Color fundus photograph — 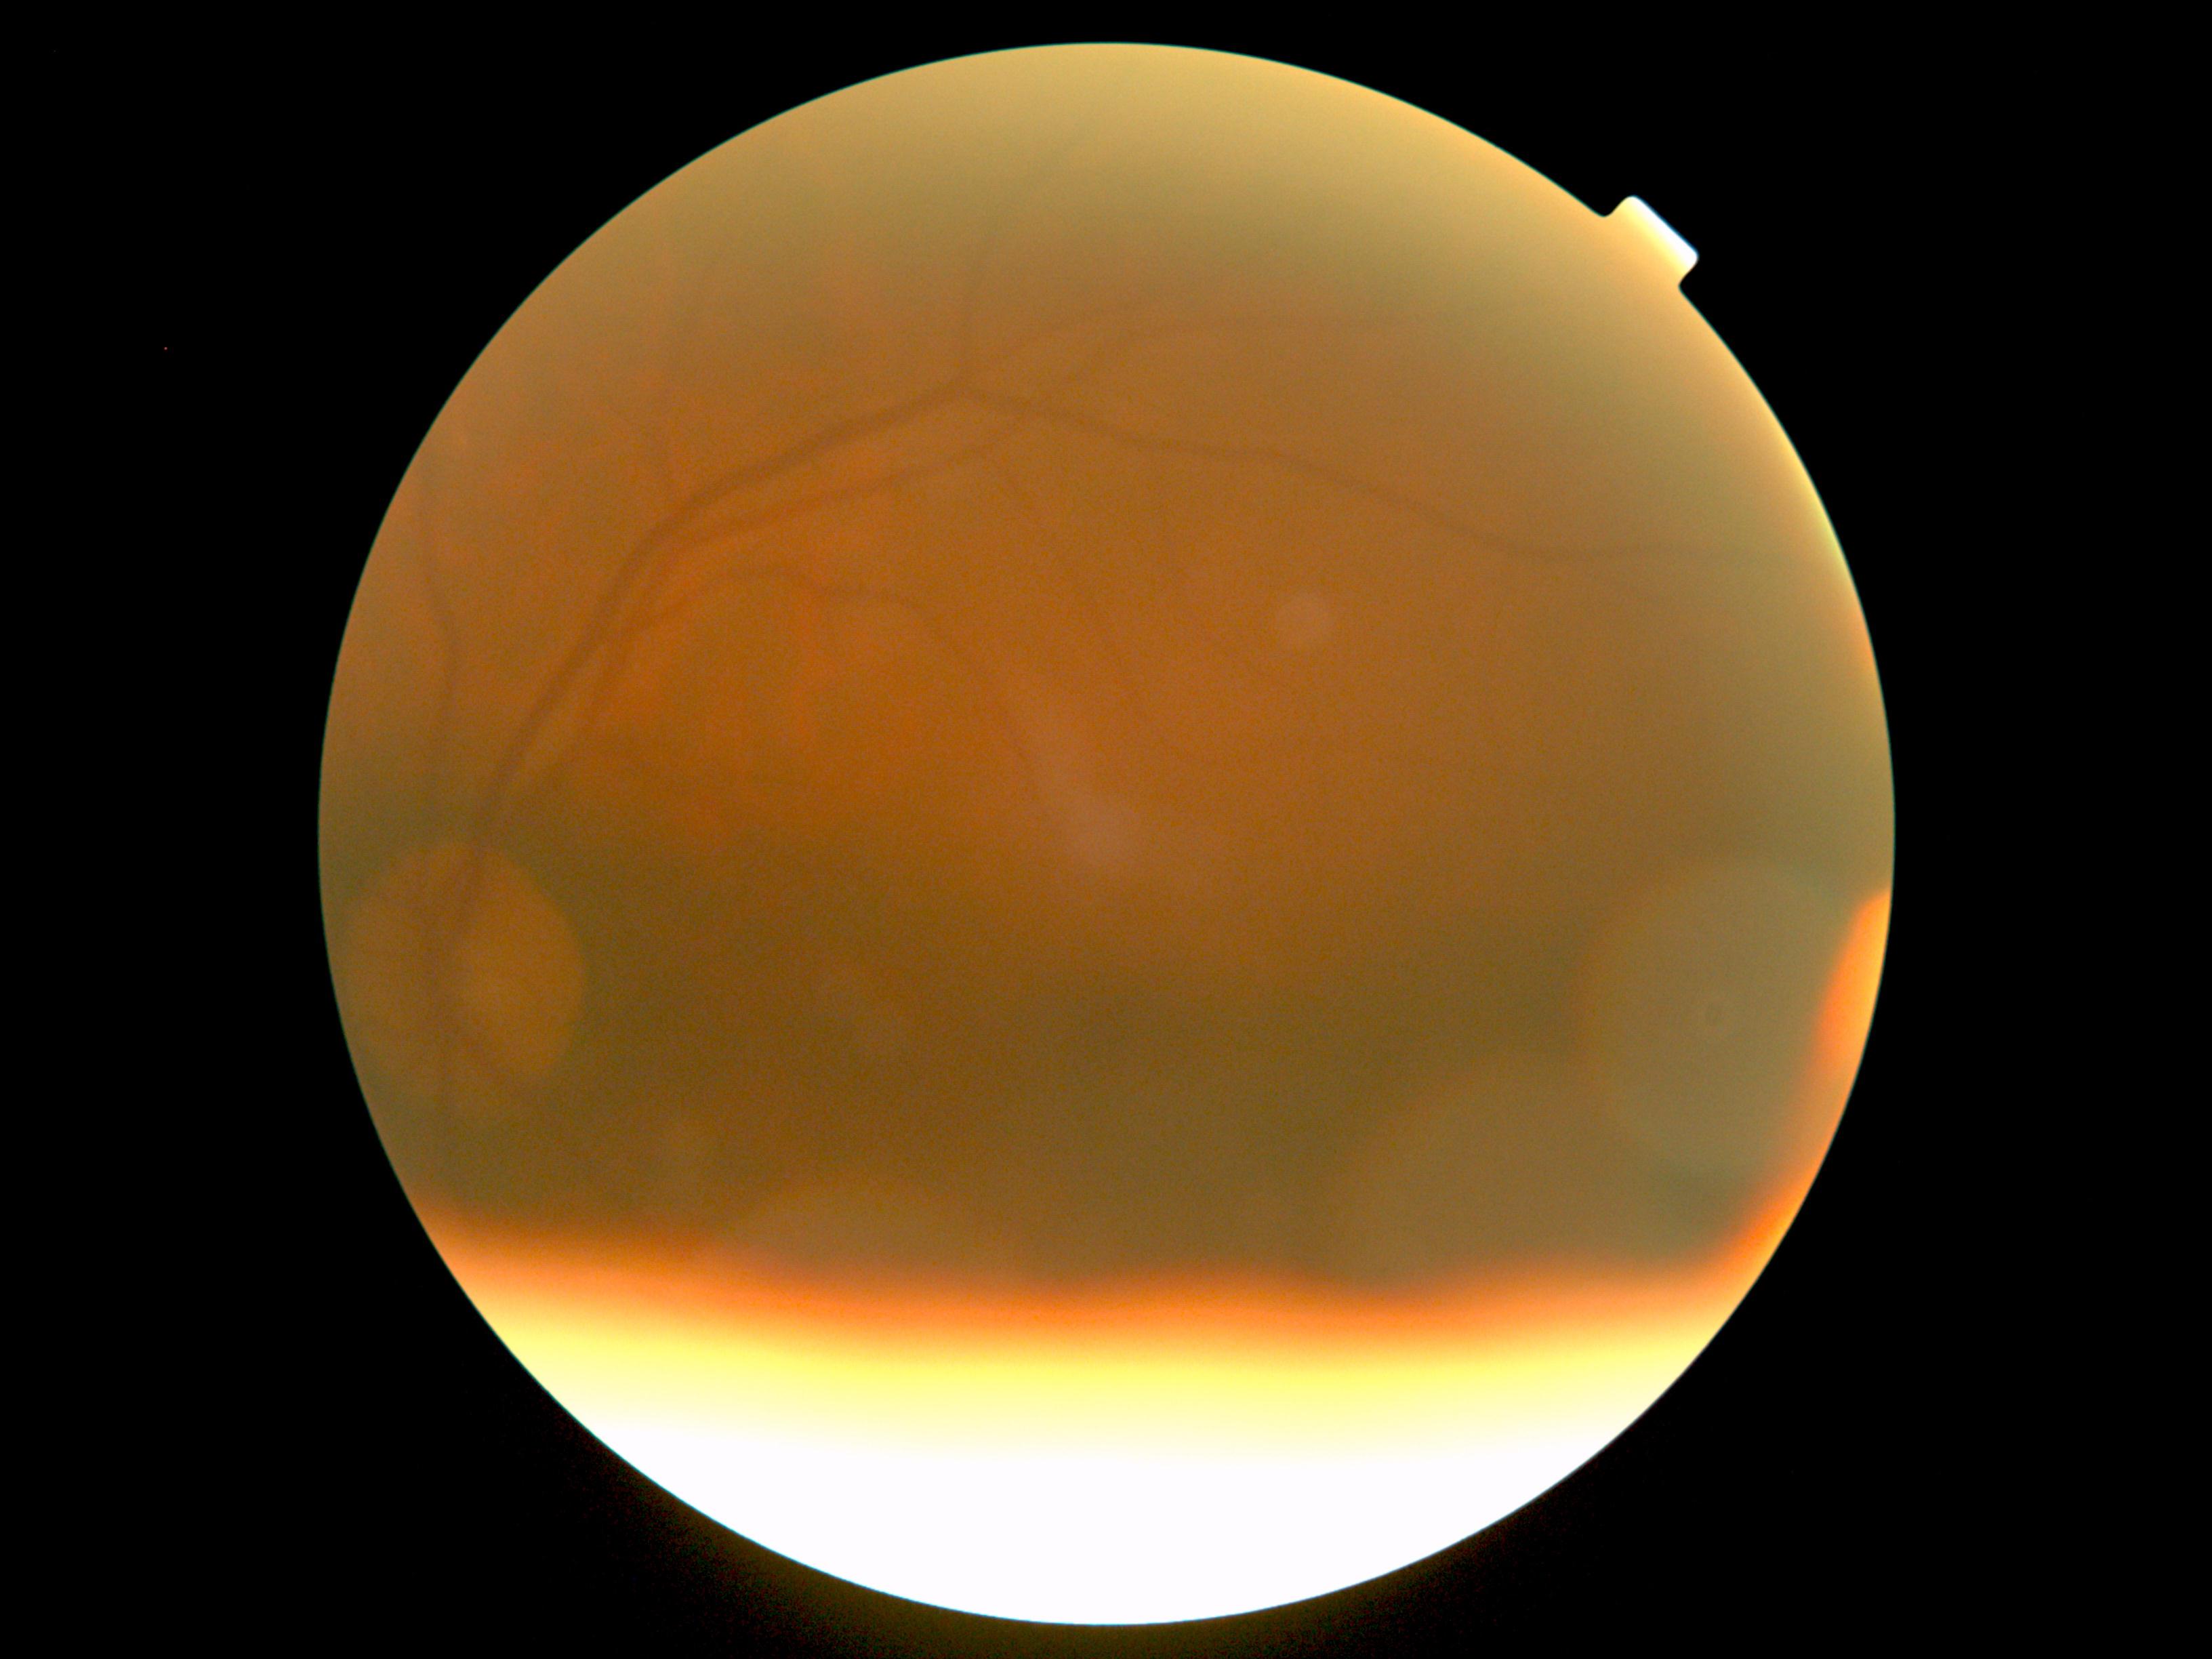
DR grade is 0.